45° field of view — 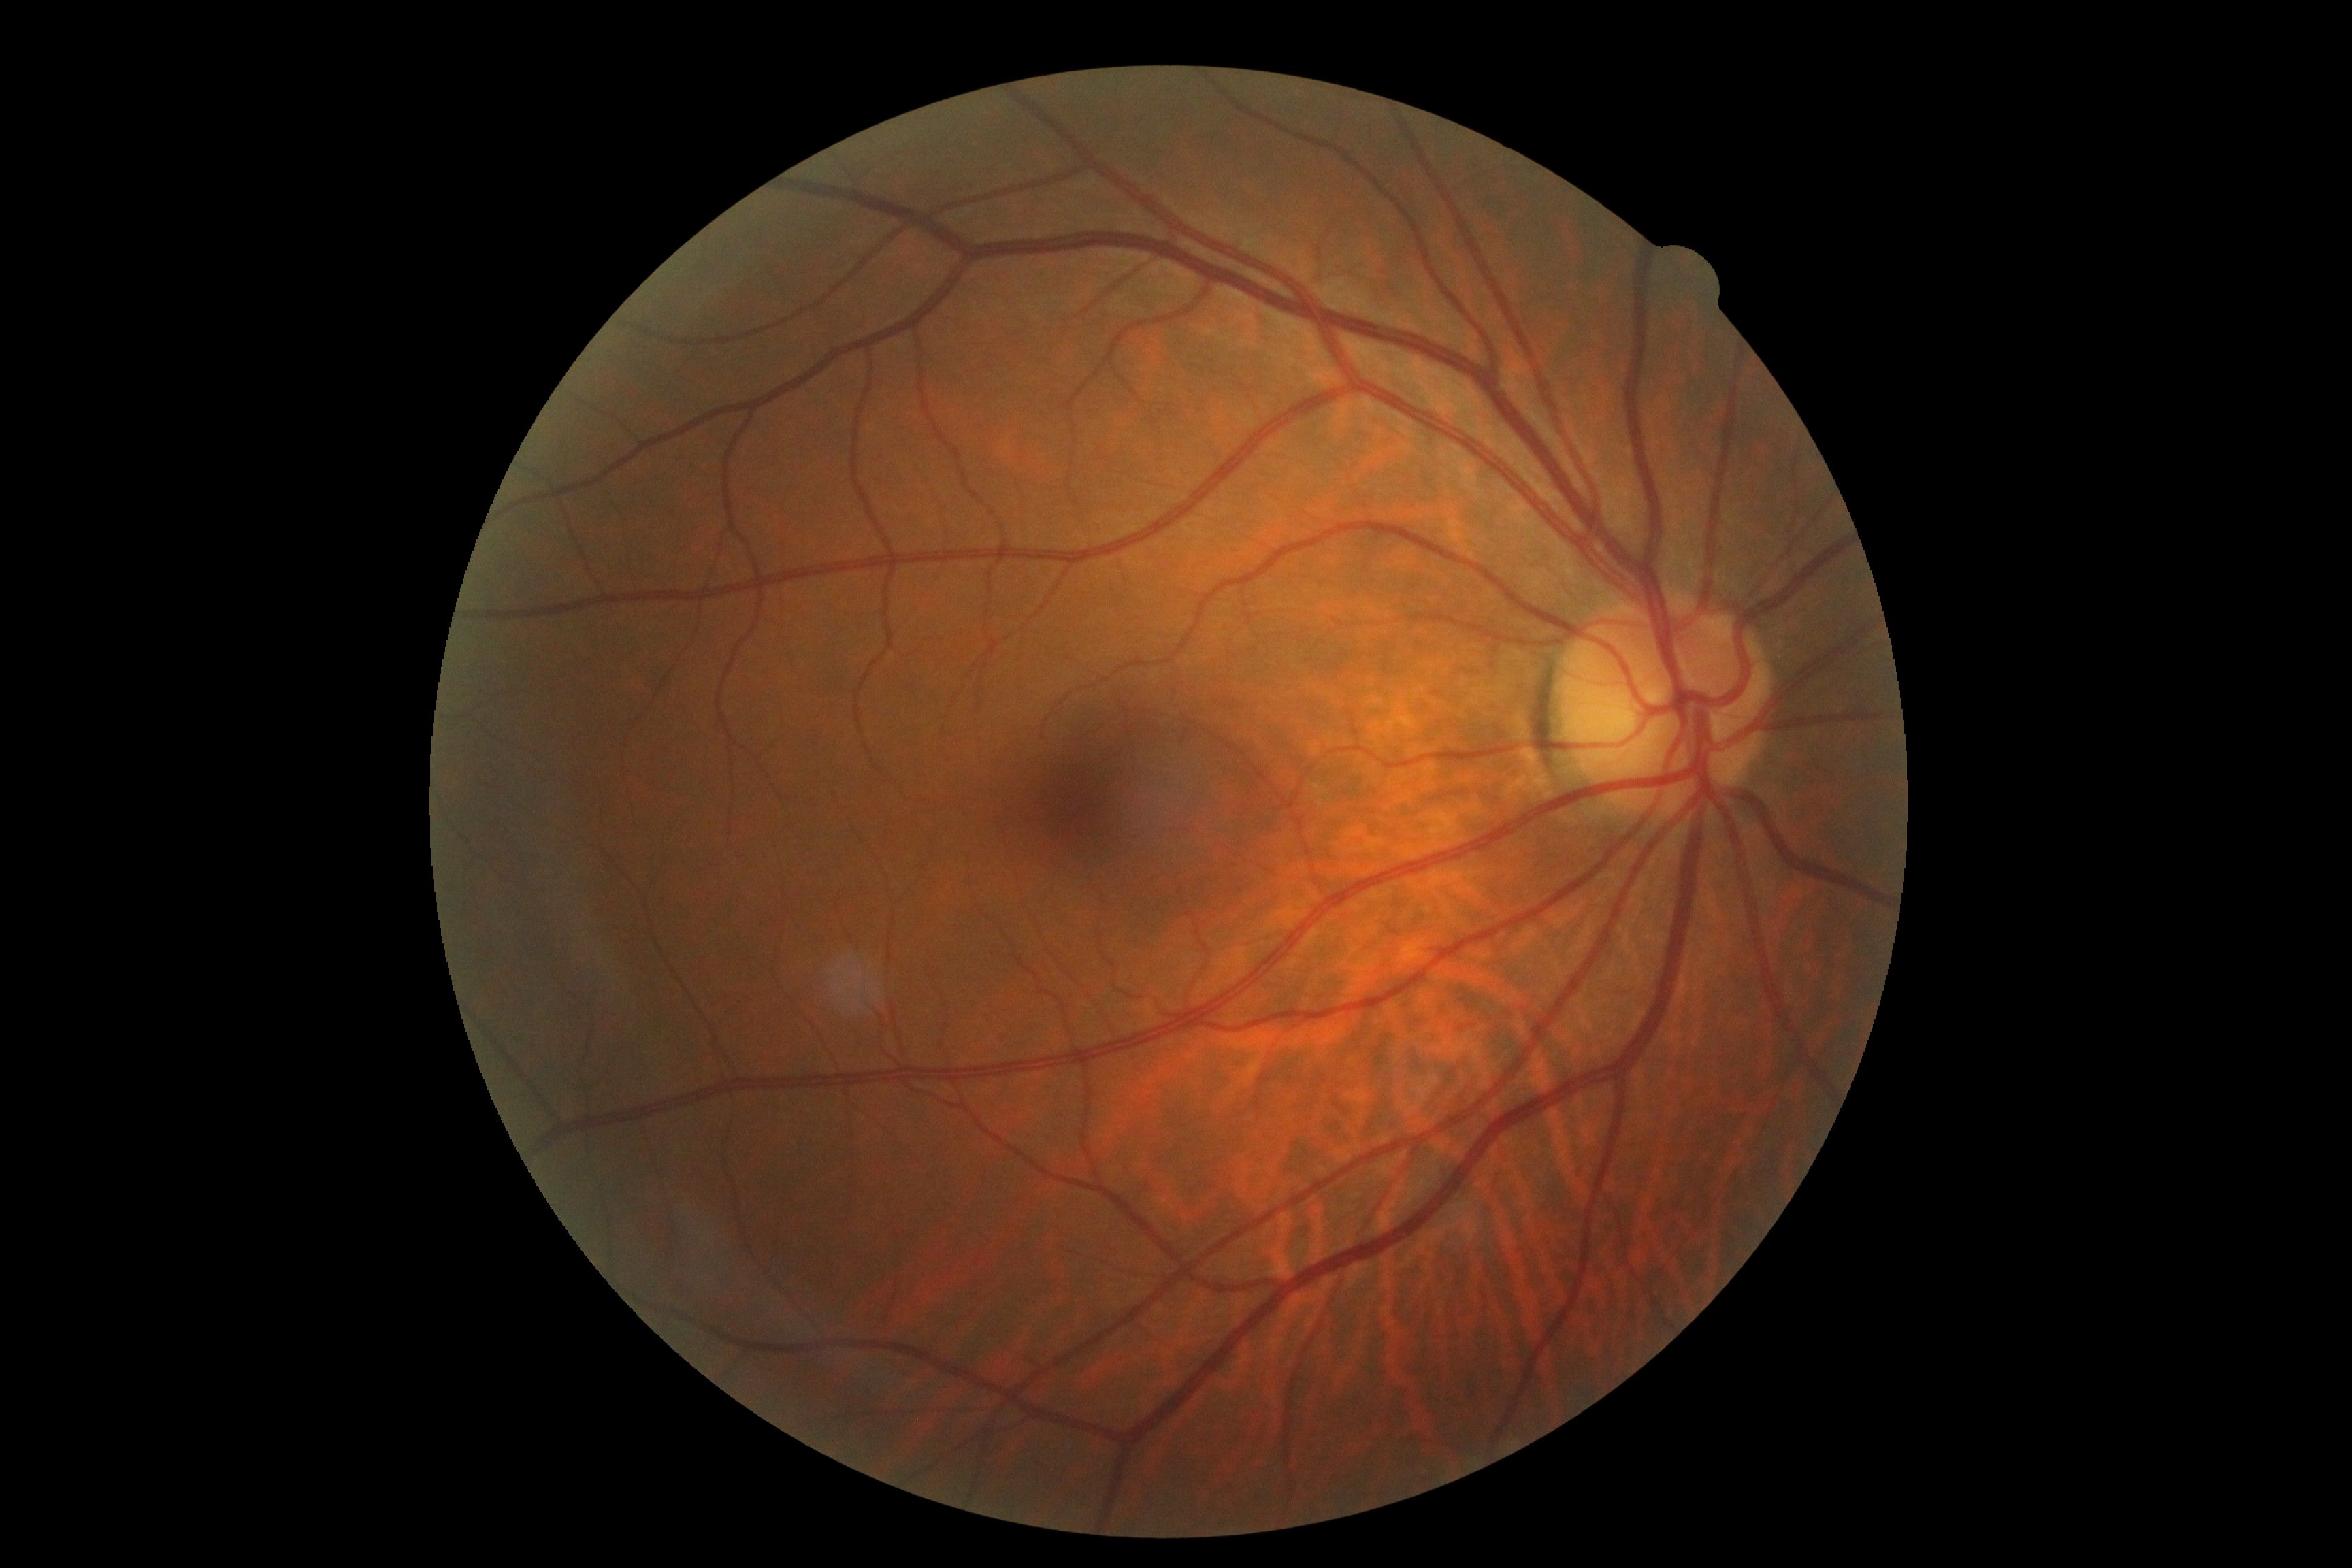
DR is 0/4 — no visible signs of diabetic retinopathy.